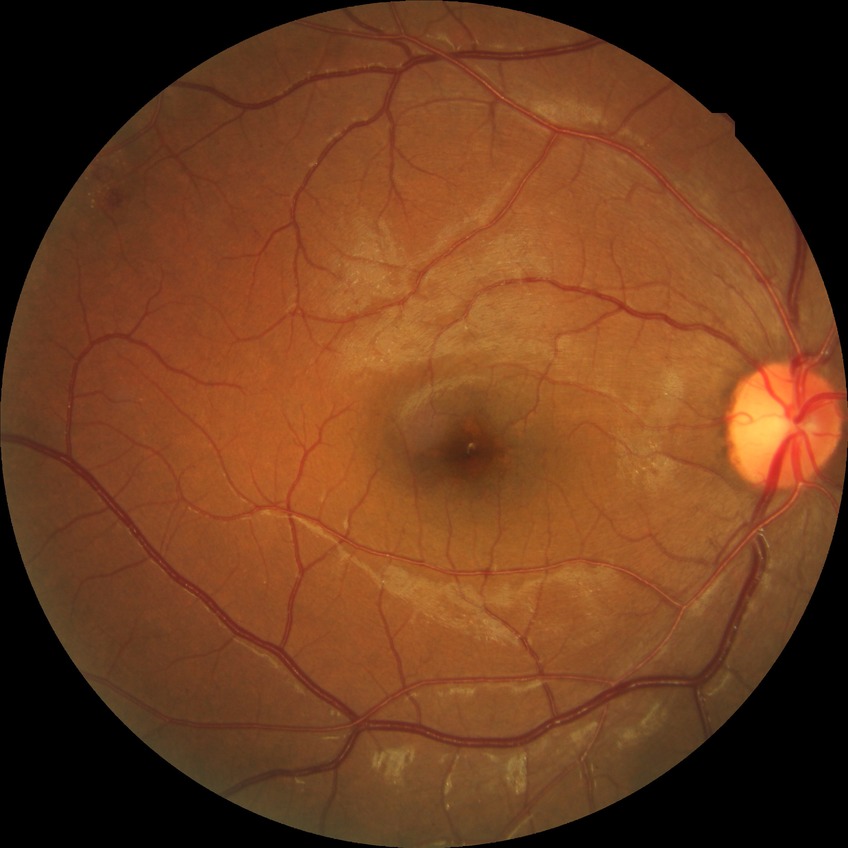
DR is SDR.